2352 by 1568 pixels — 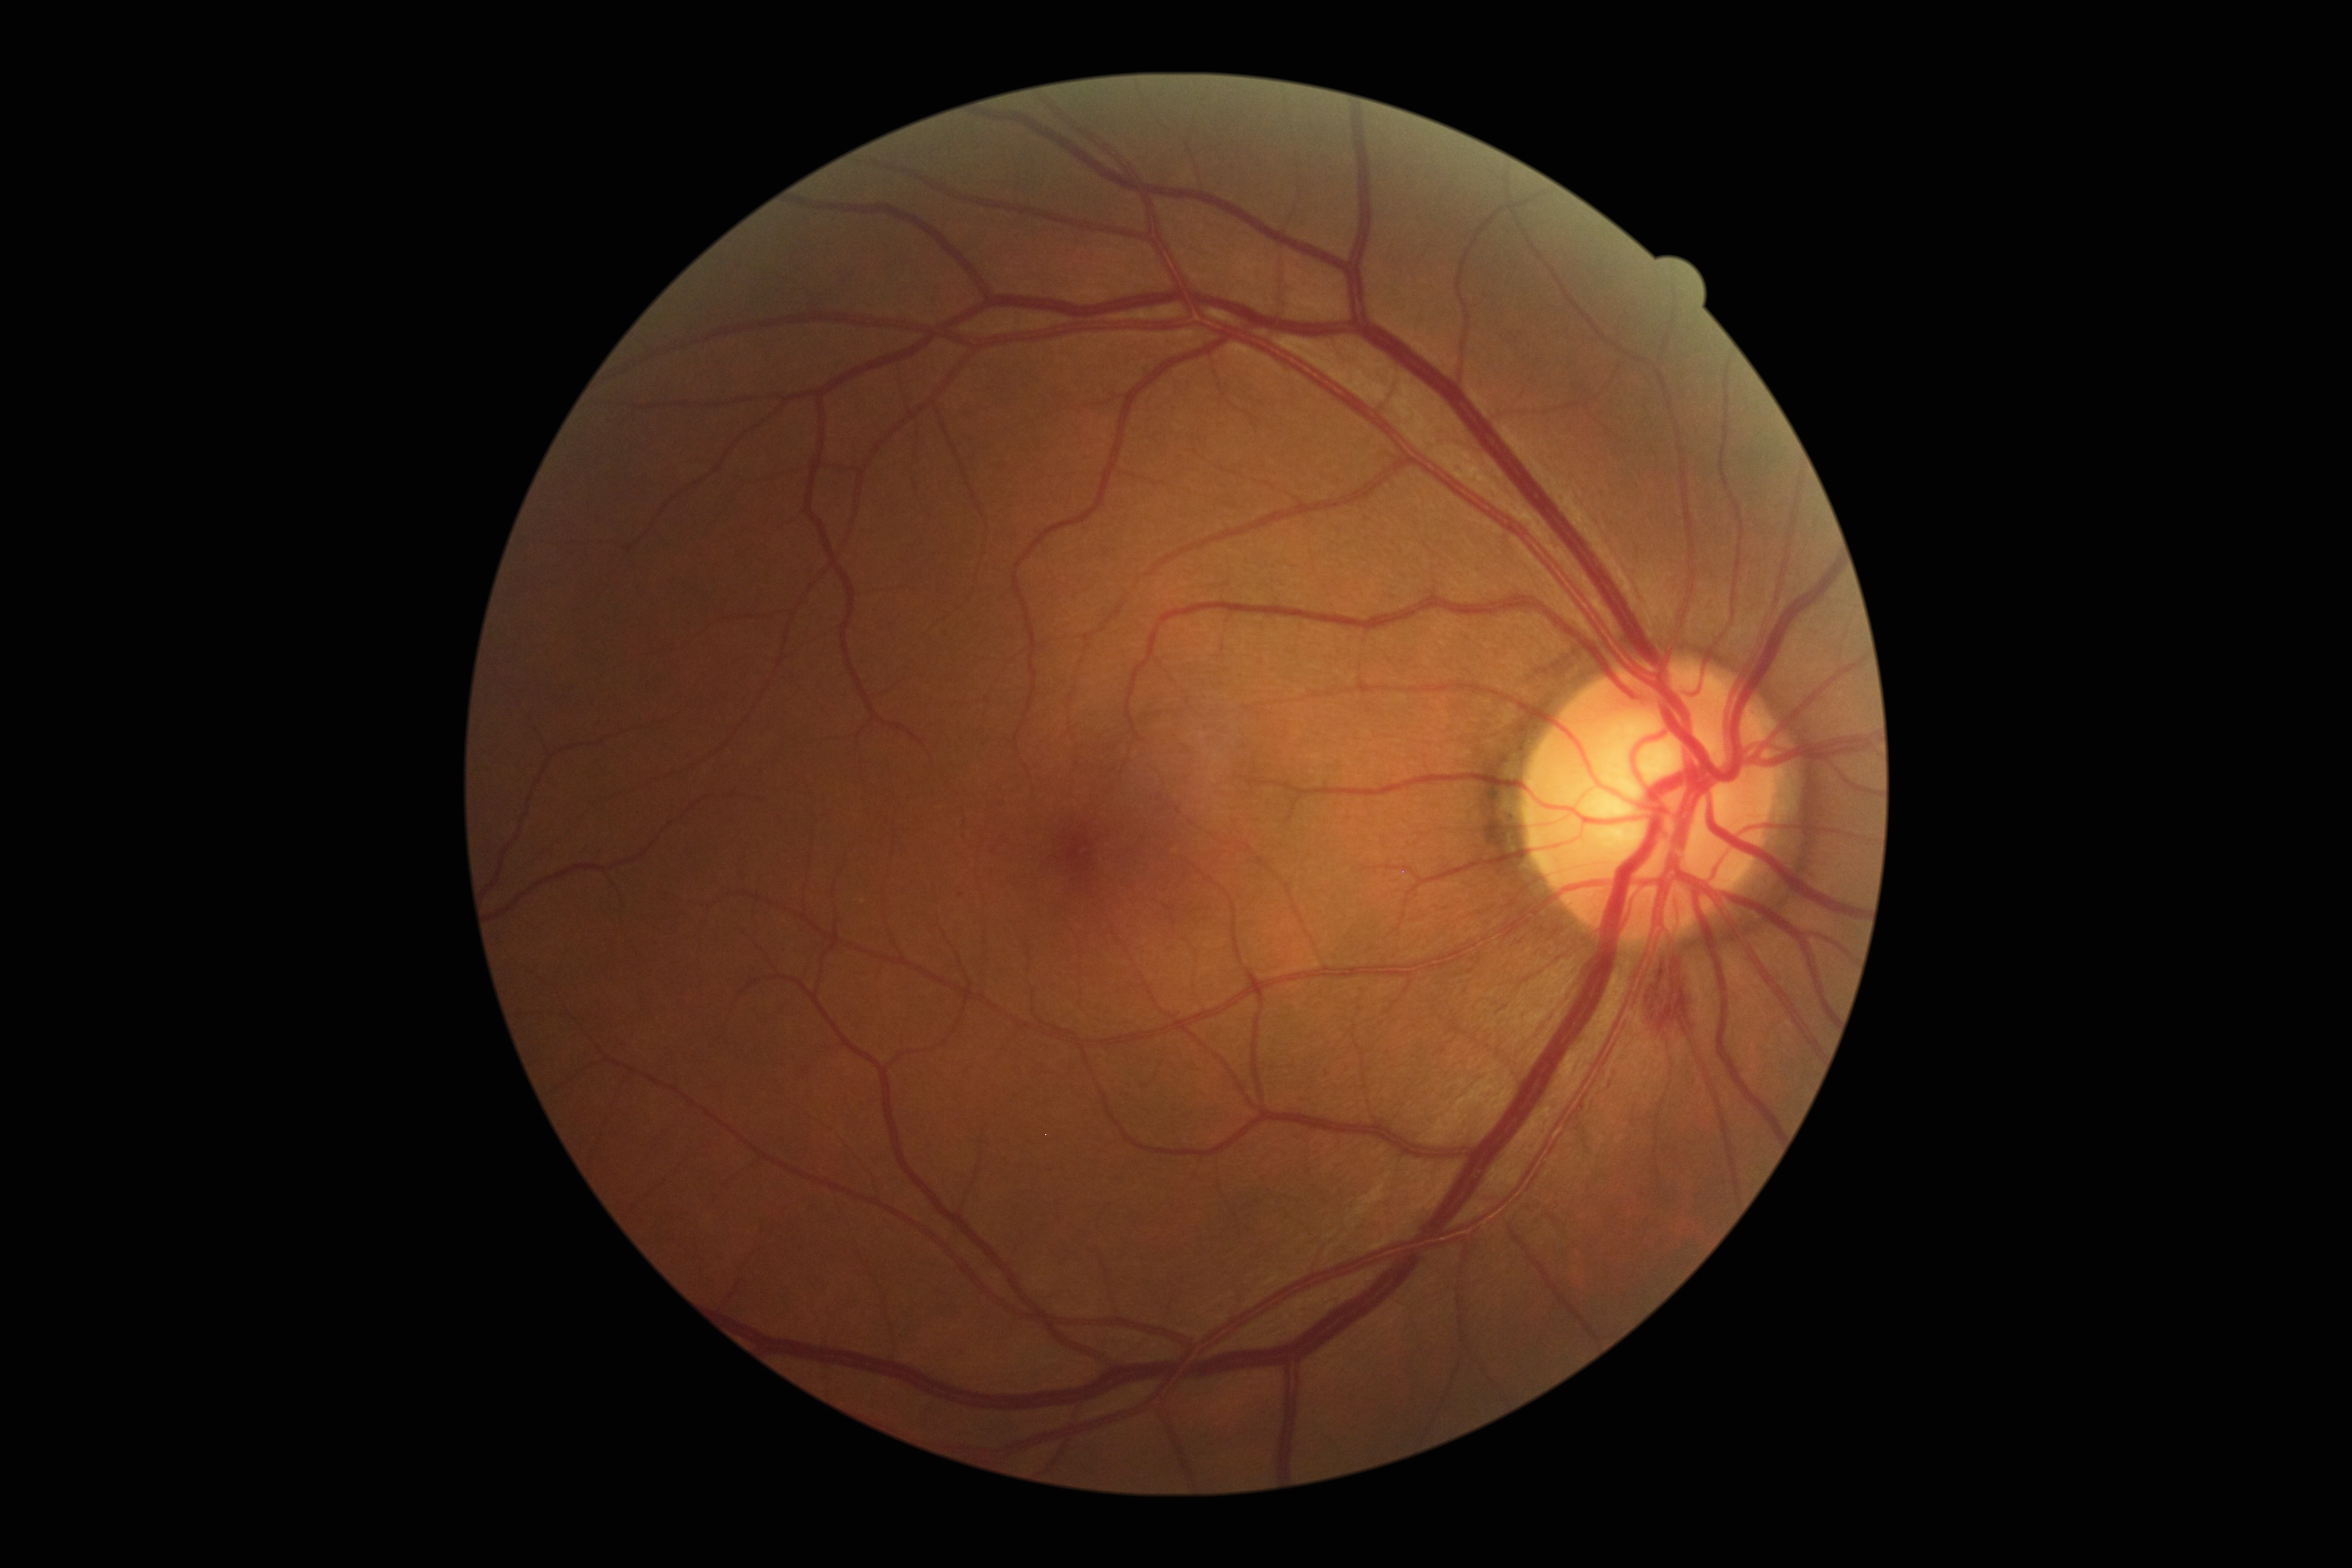
{
  "dr_category": "non-proliferative diabetic retinopathy",
  "dr_grade": "grade 2"
}